FOV 35° before cropping, fundus photograph cropped around the optic nerve head — 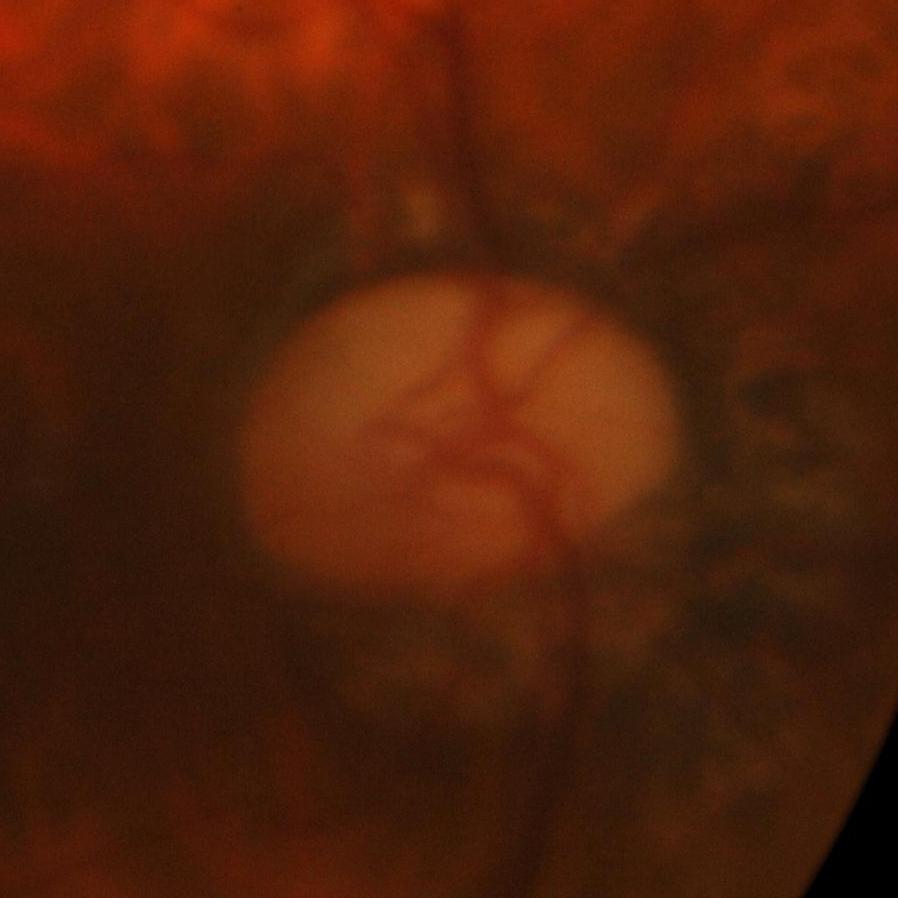 Glaucoma diagnosis = glaucomatous changes.